848 x 848 pixels, acquired with a NIDEK AFC-230: 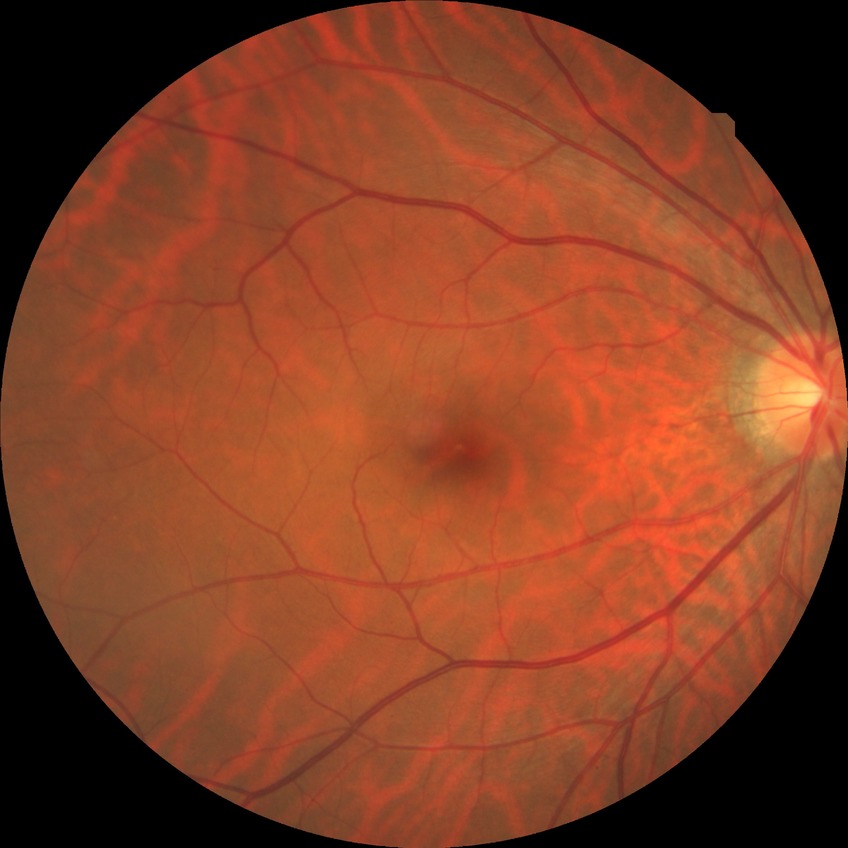
Davis grading is no diabetic retinopathy.